45° field of view
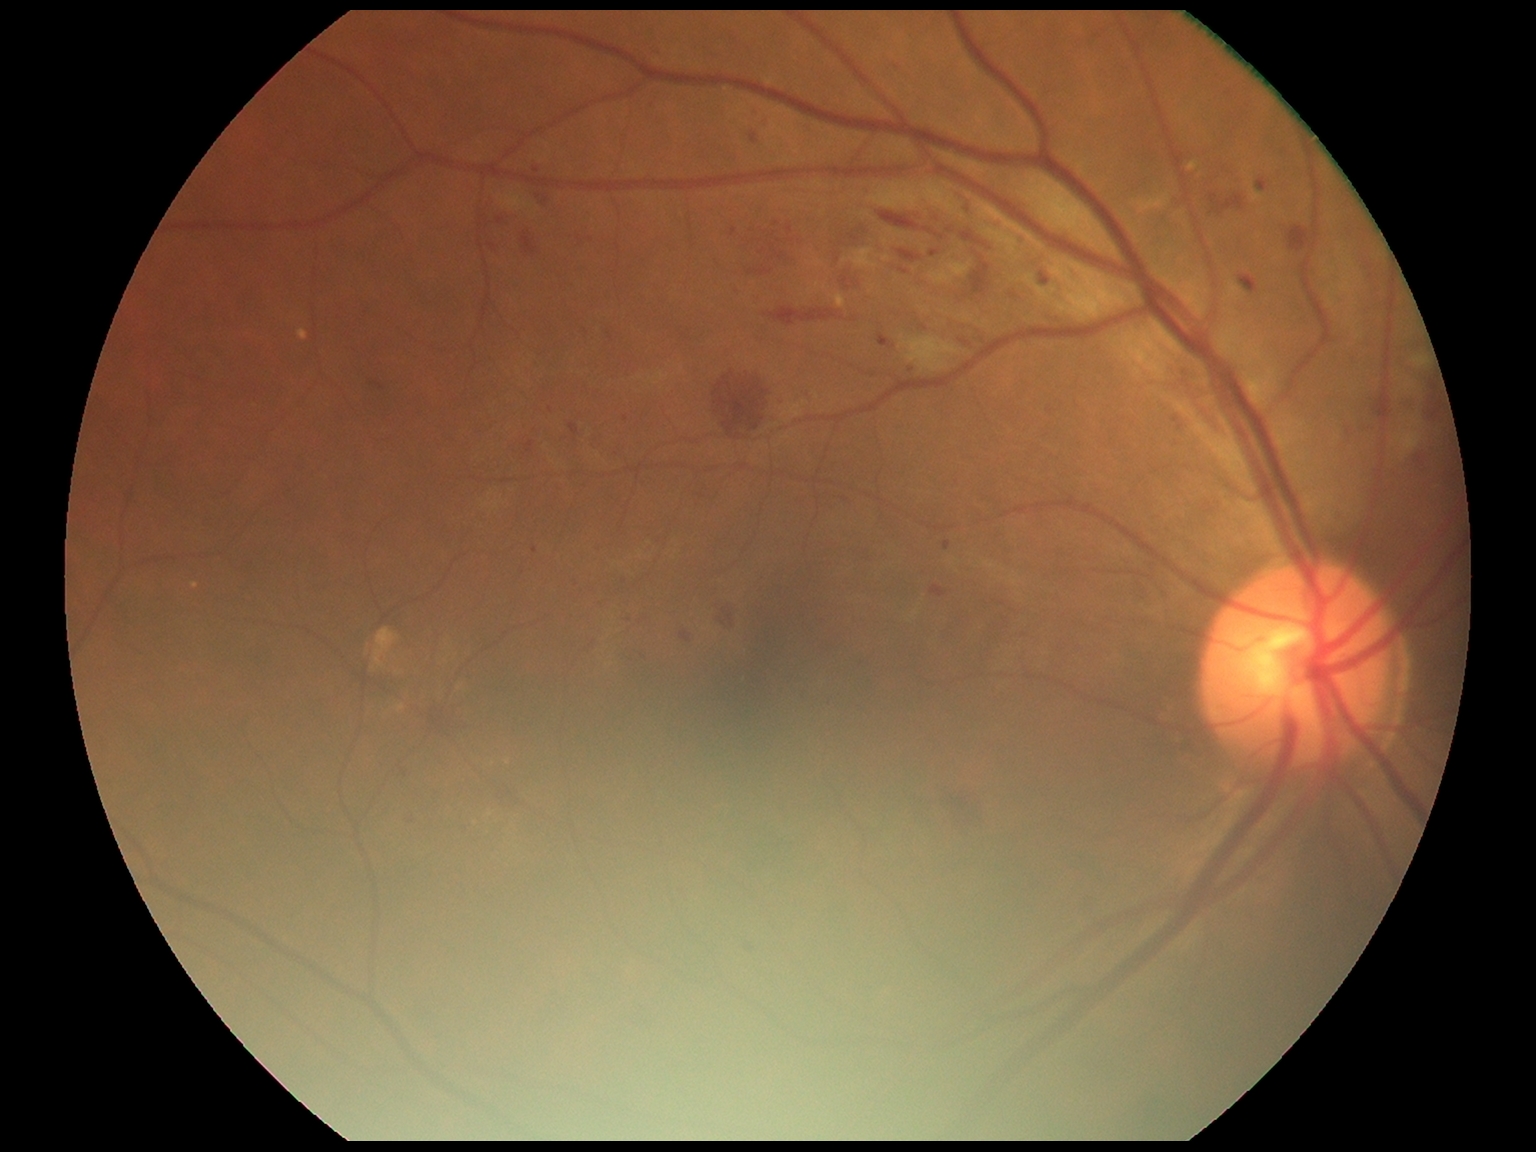 DR class: non-proliferative diabetic retinopathy.
Diabetic retinopathy is moderate NPDR (grade 2).